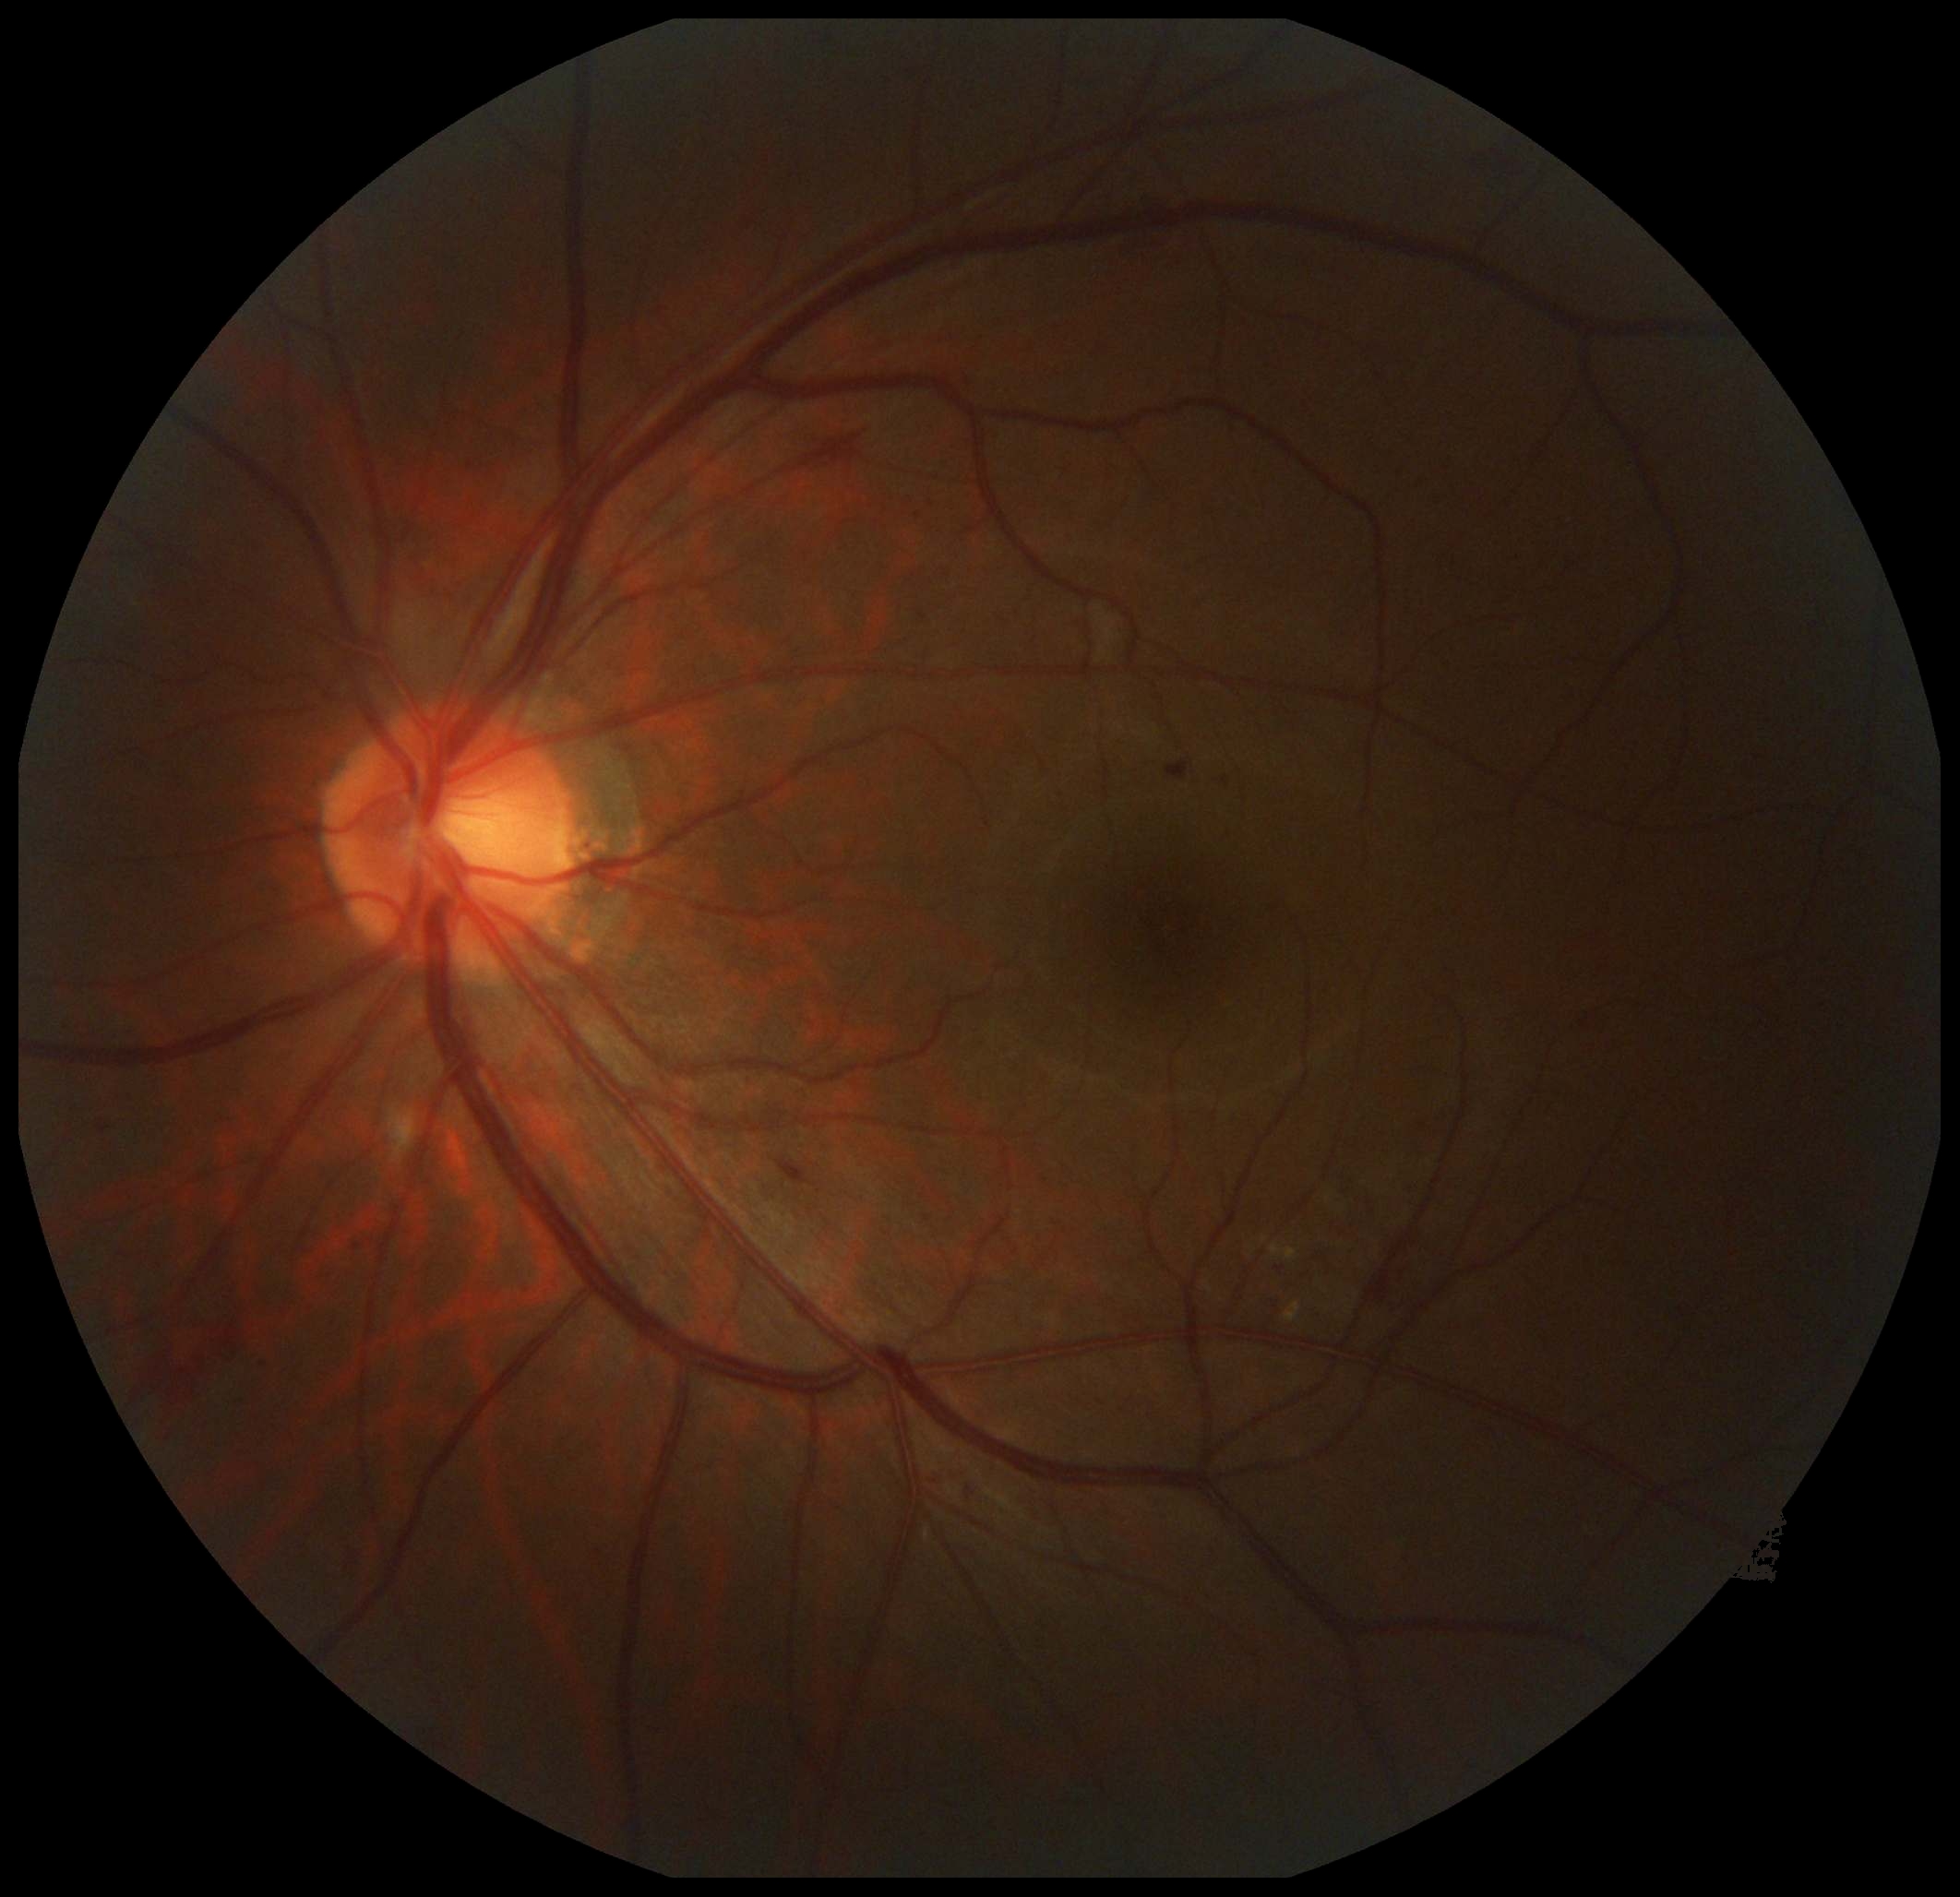

The retinopathy is classified as non-proliferative diabetic retinopathy. Diabetic retinopathy is grade 2 (moderate NPDR) — more than just microaneurysms but less than severe NPDR.